Modified Davis classification.
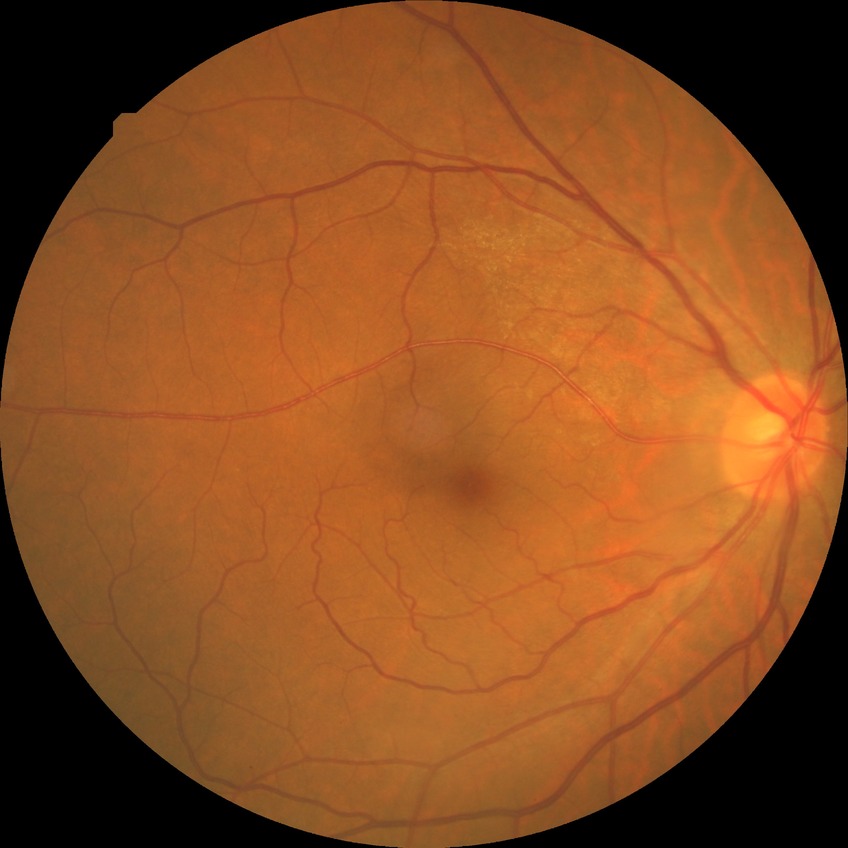

{"davis_grade": "no diabetic retinopathy (NDR)"}